45-degree field of view — 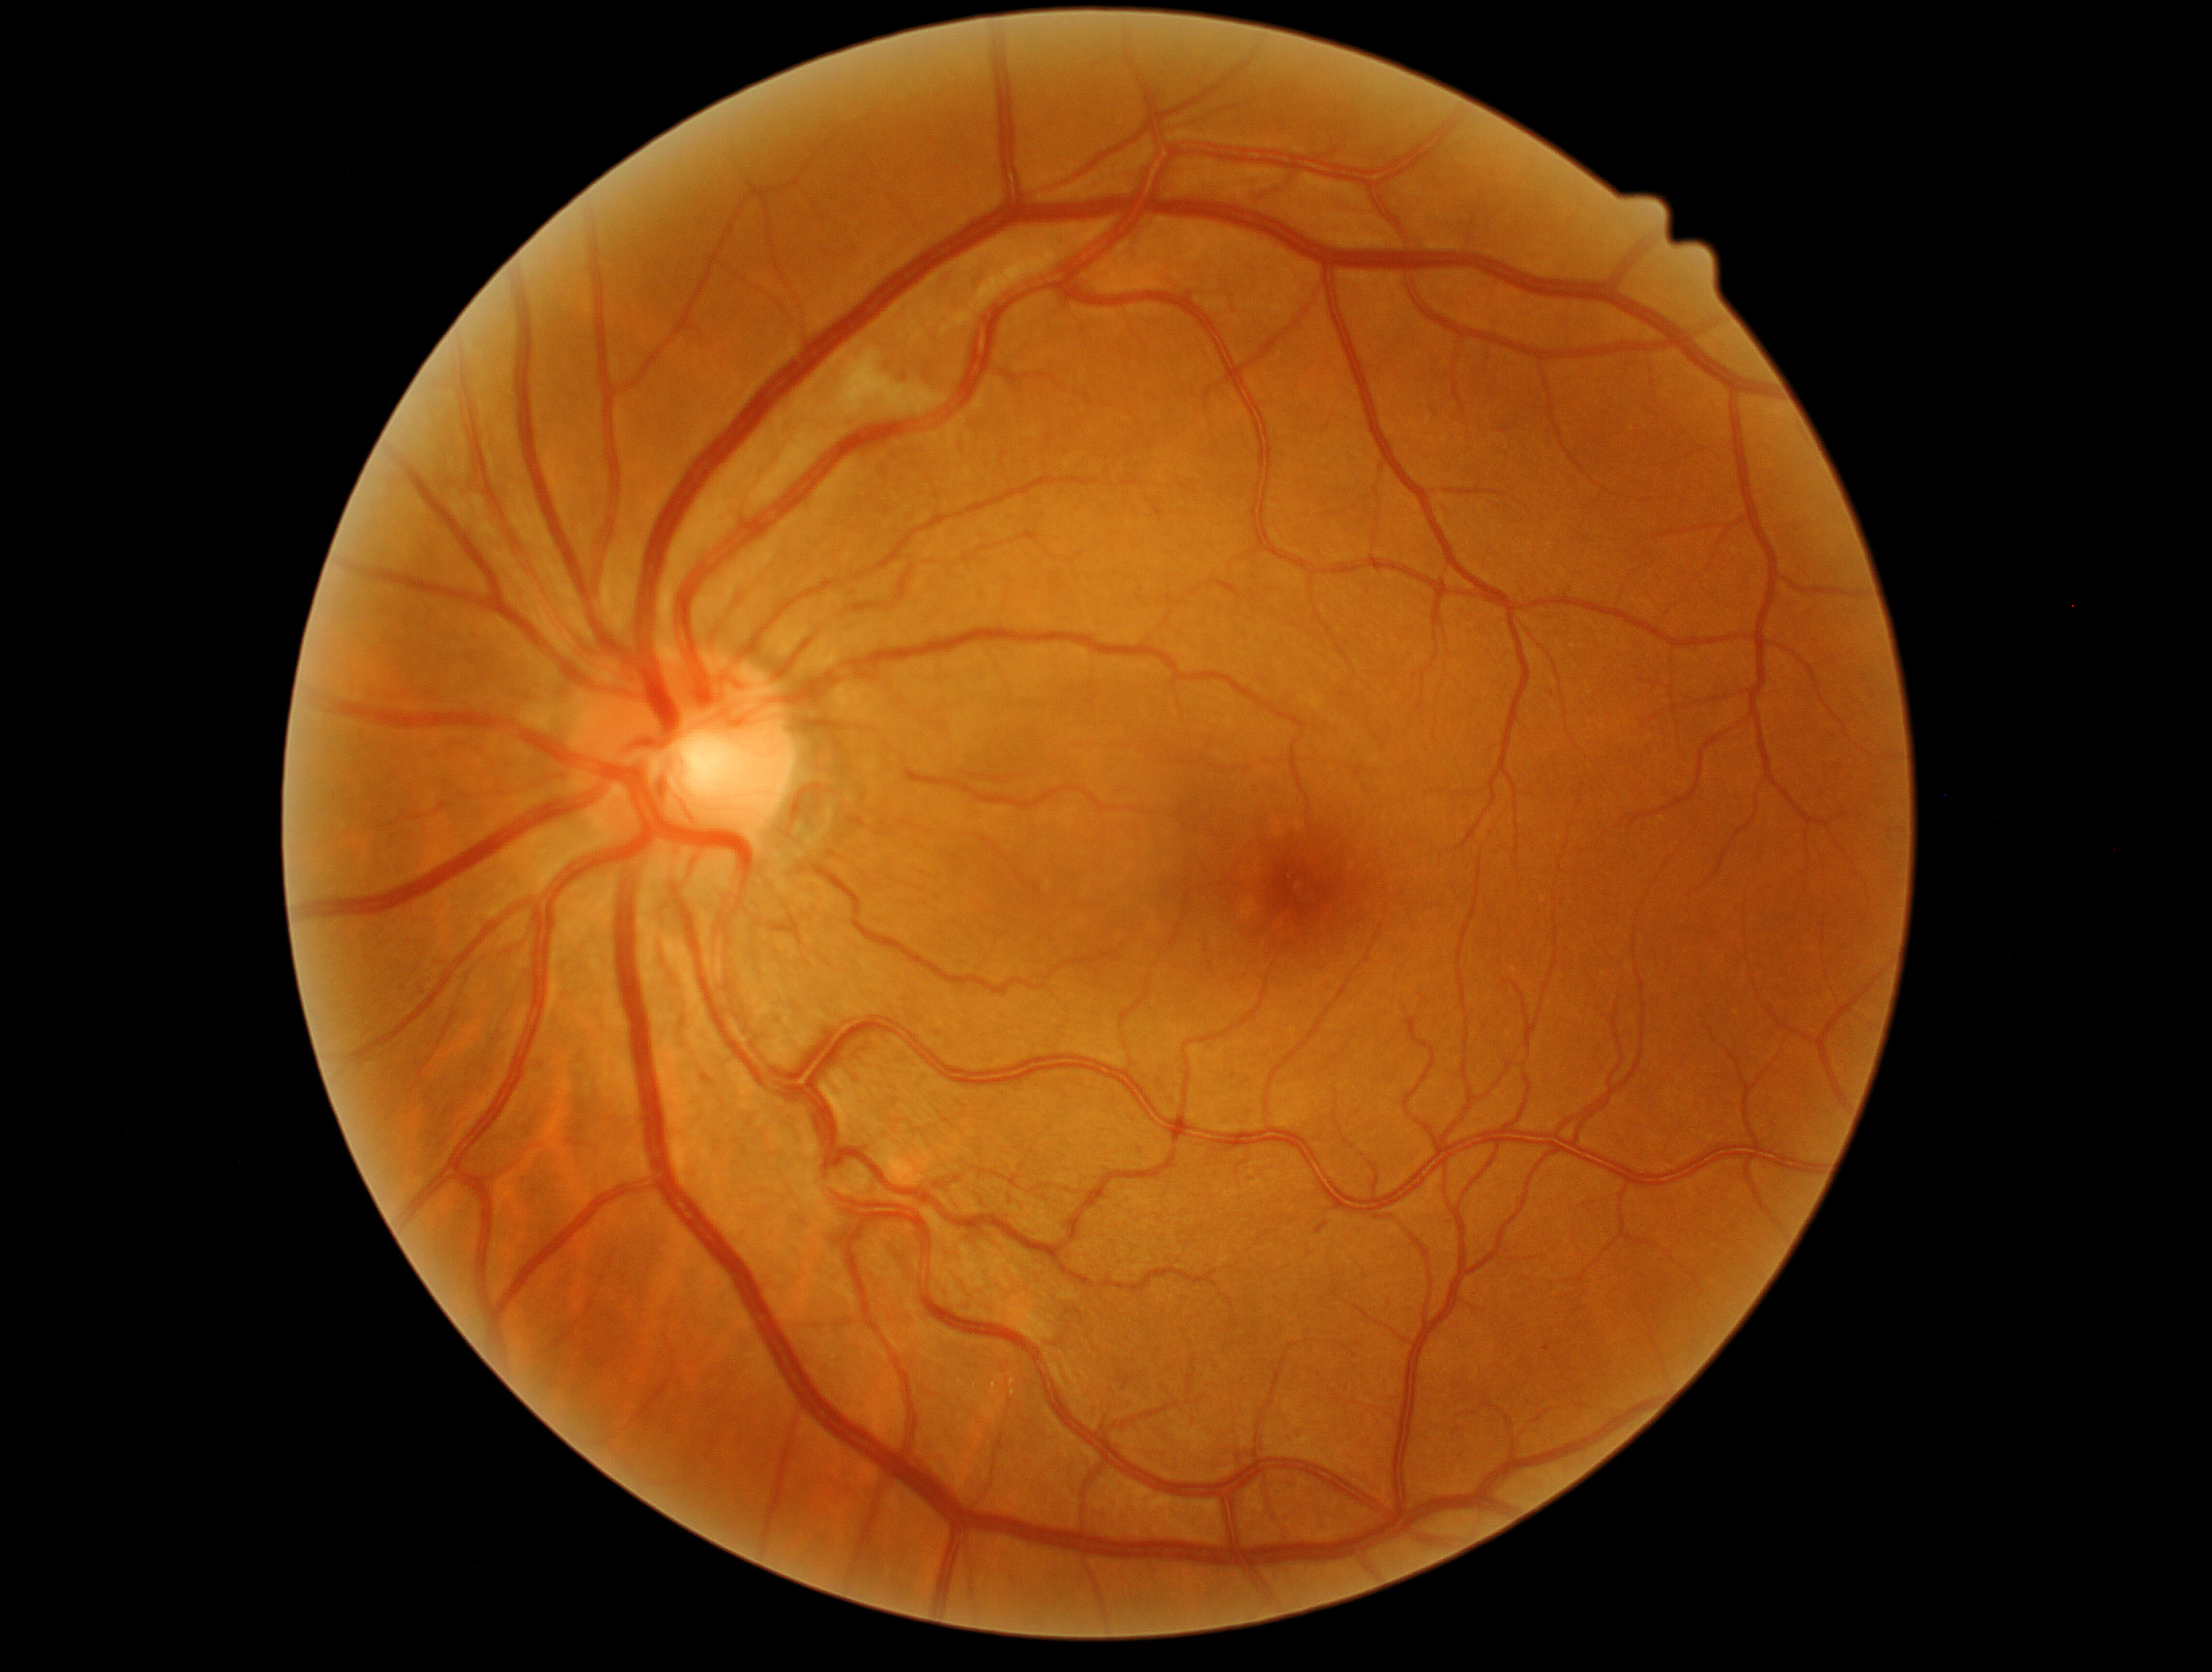

Diabetic retinopathy severity is grade 2 (moderate NPDR).